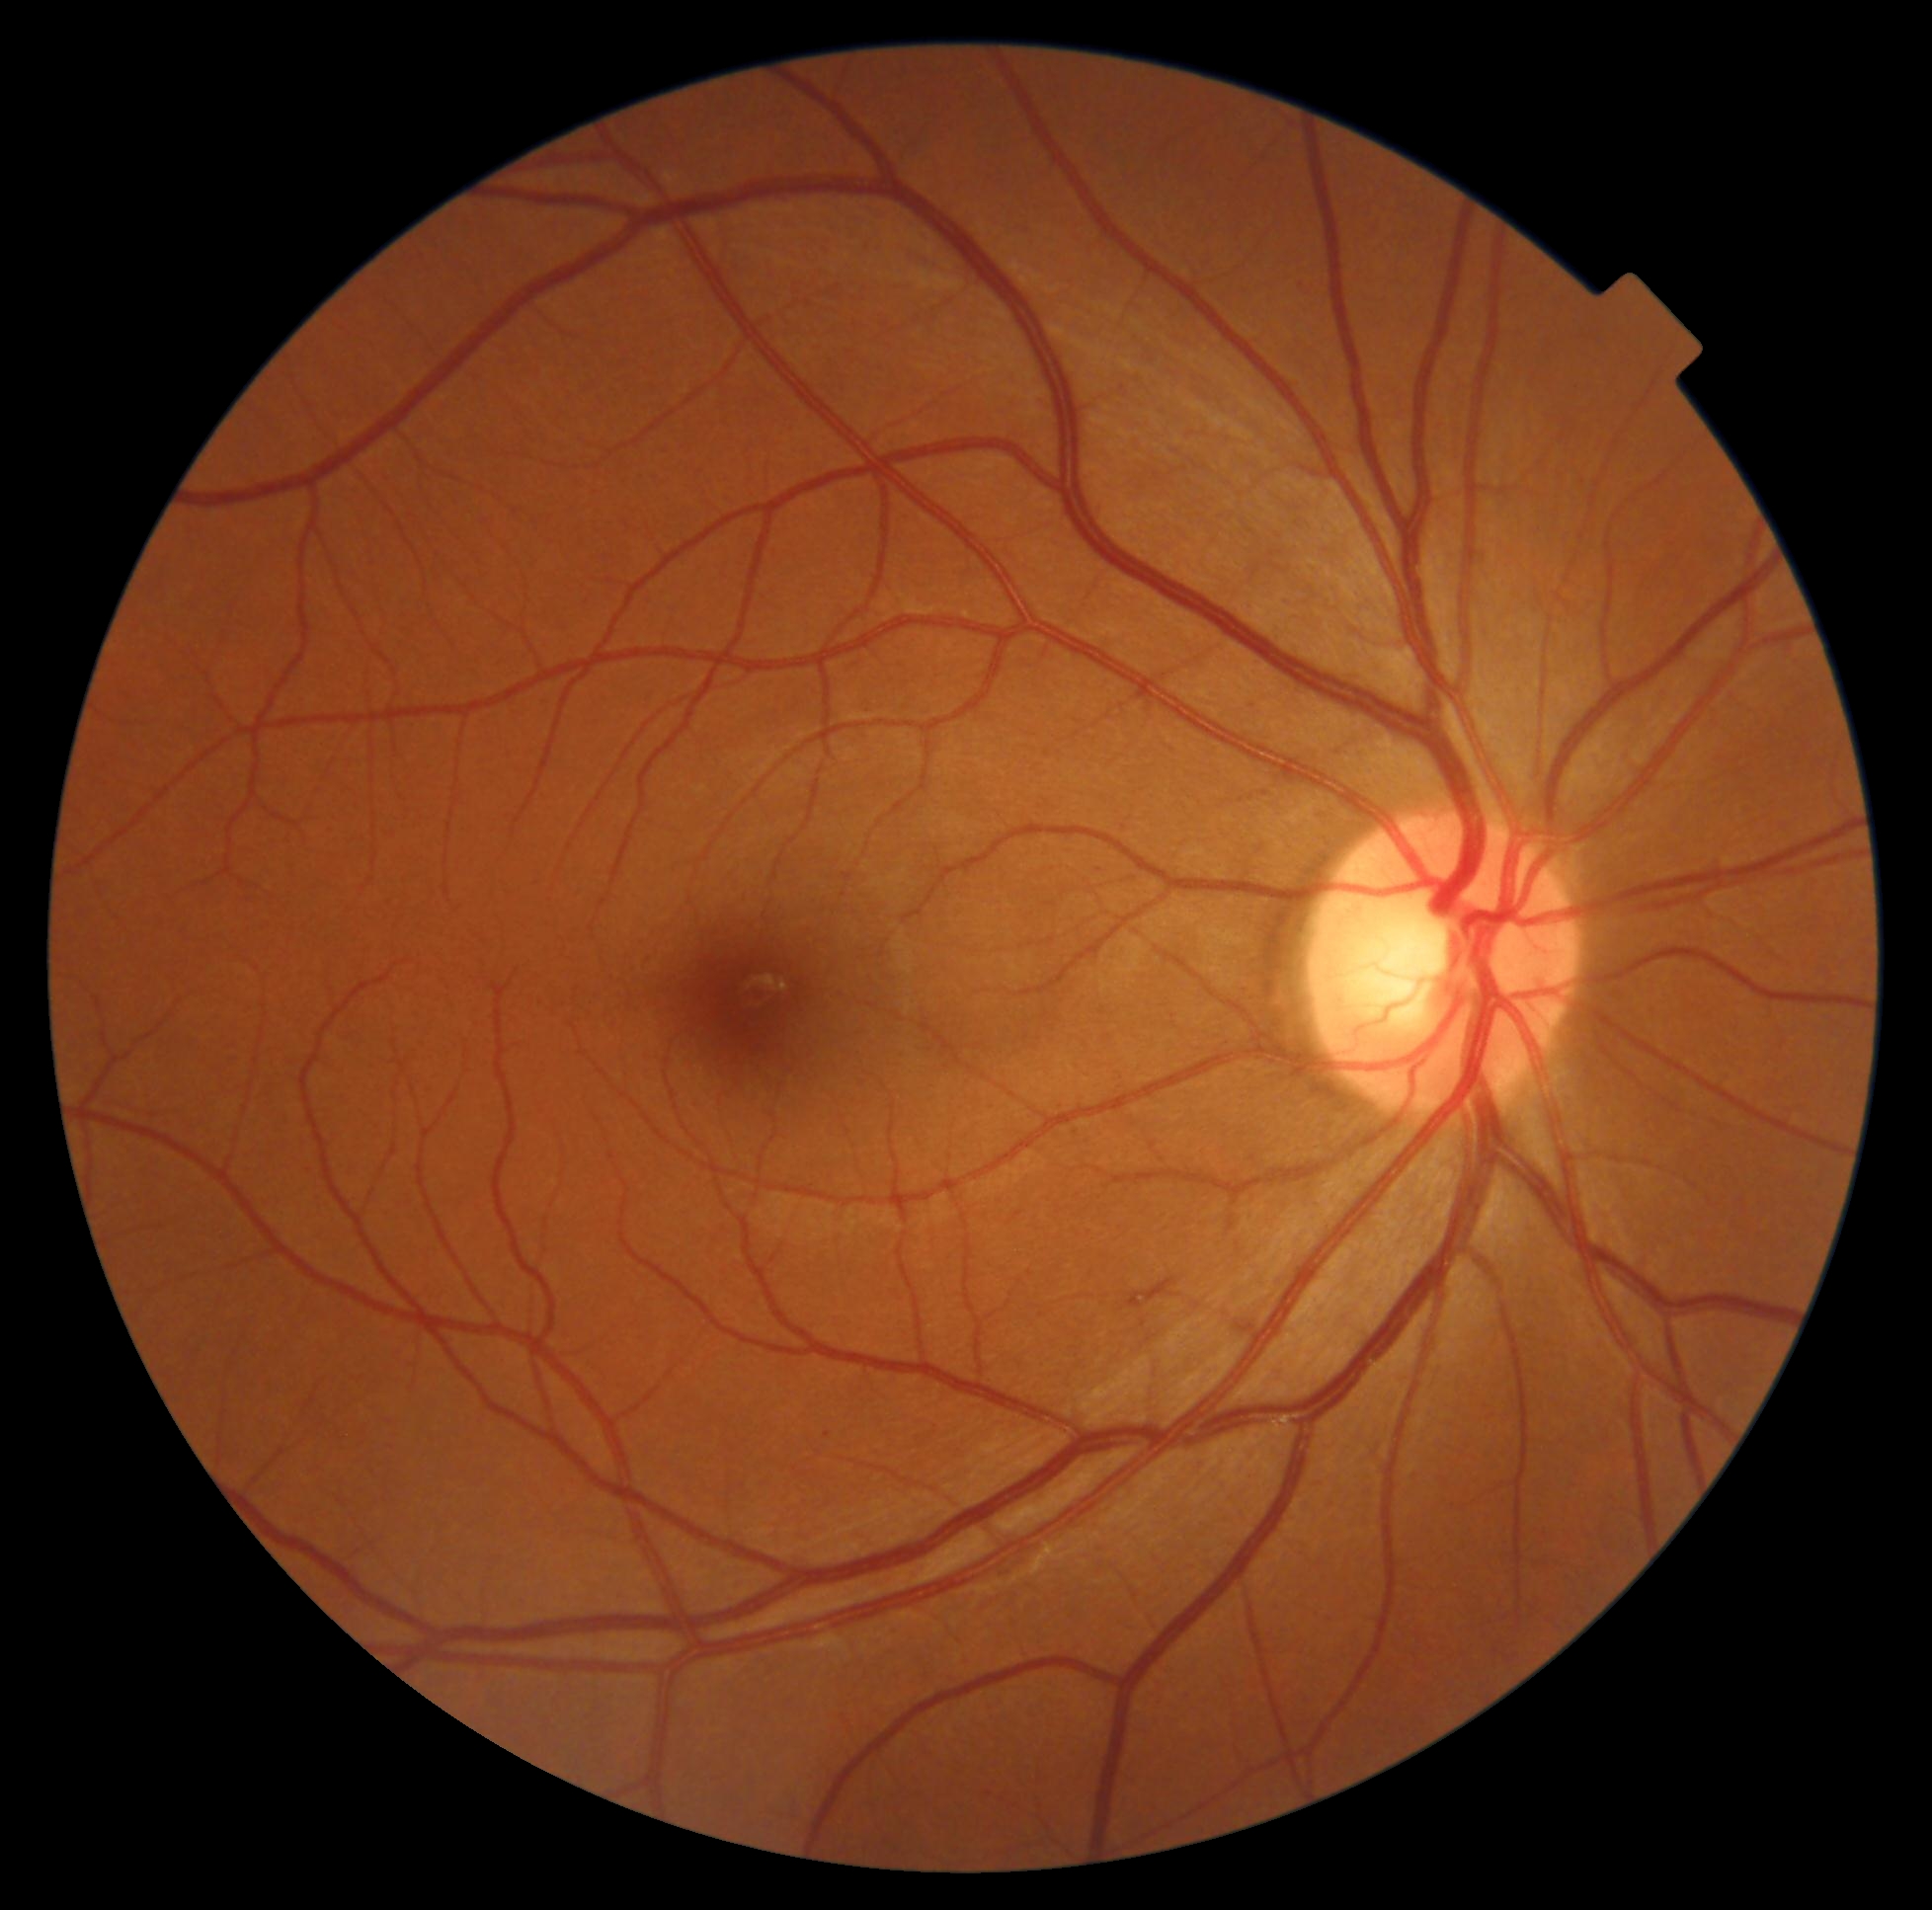

DR class = non-proliferative diabetic retinopathy; DR grade = 2.